Image size 2346x1568.
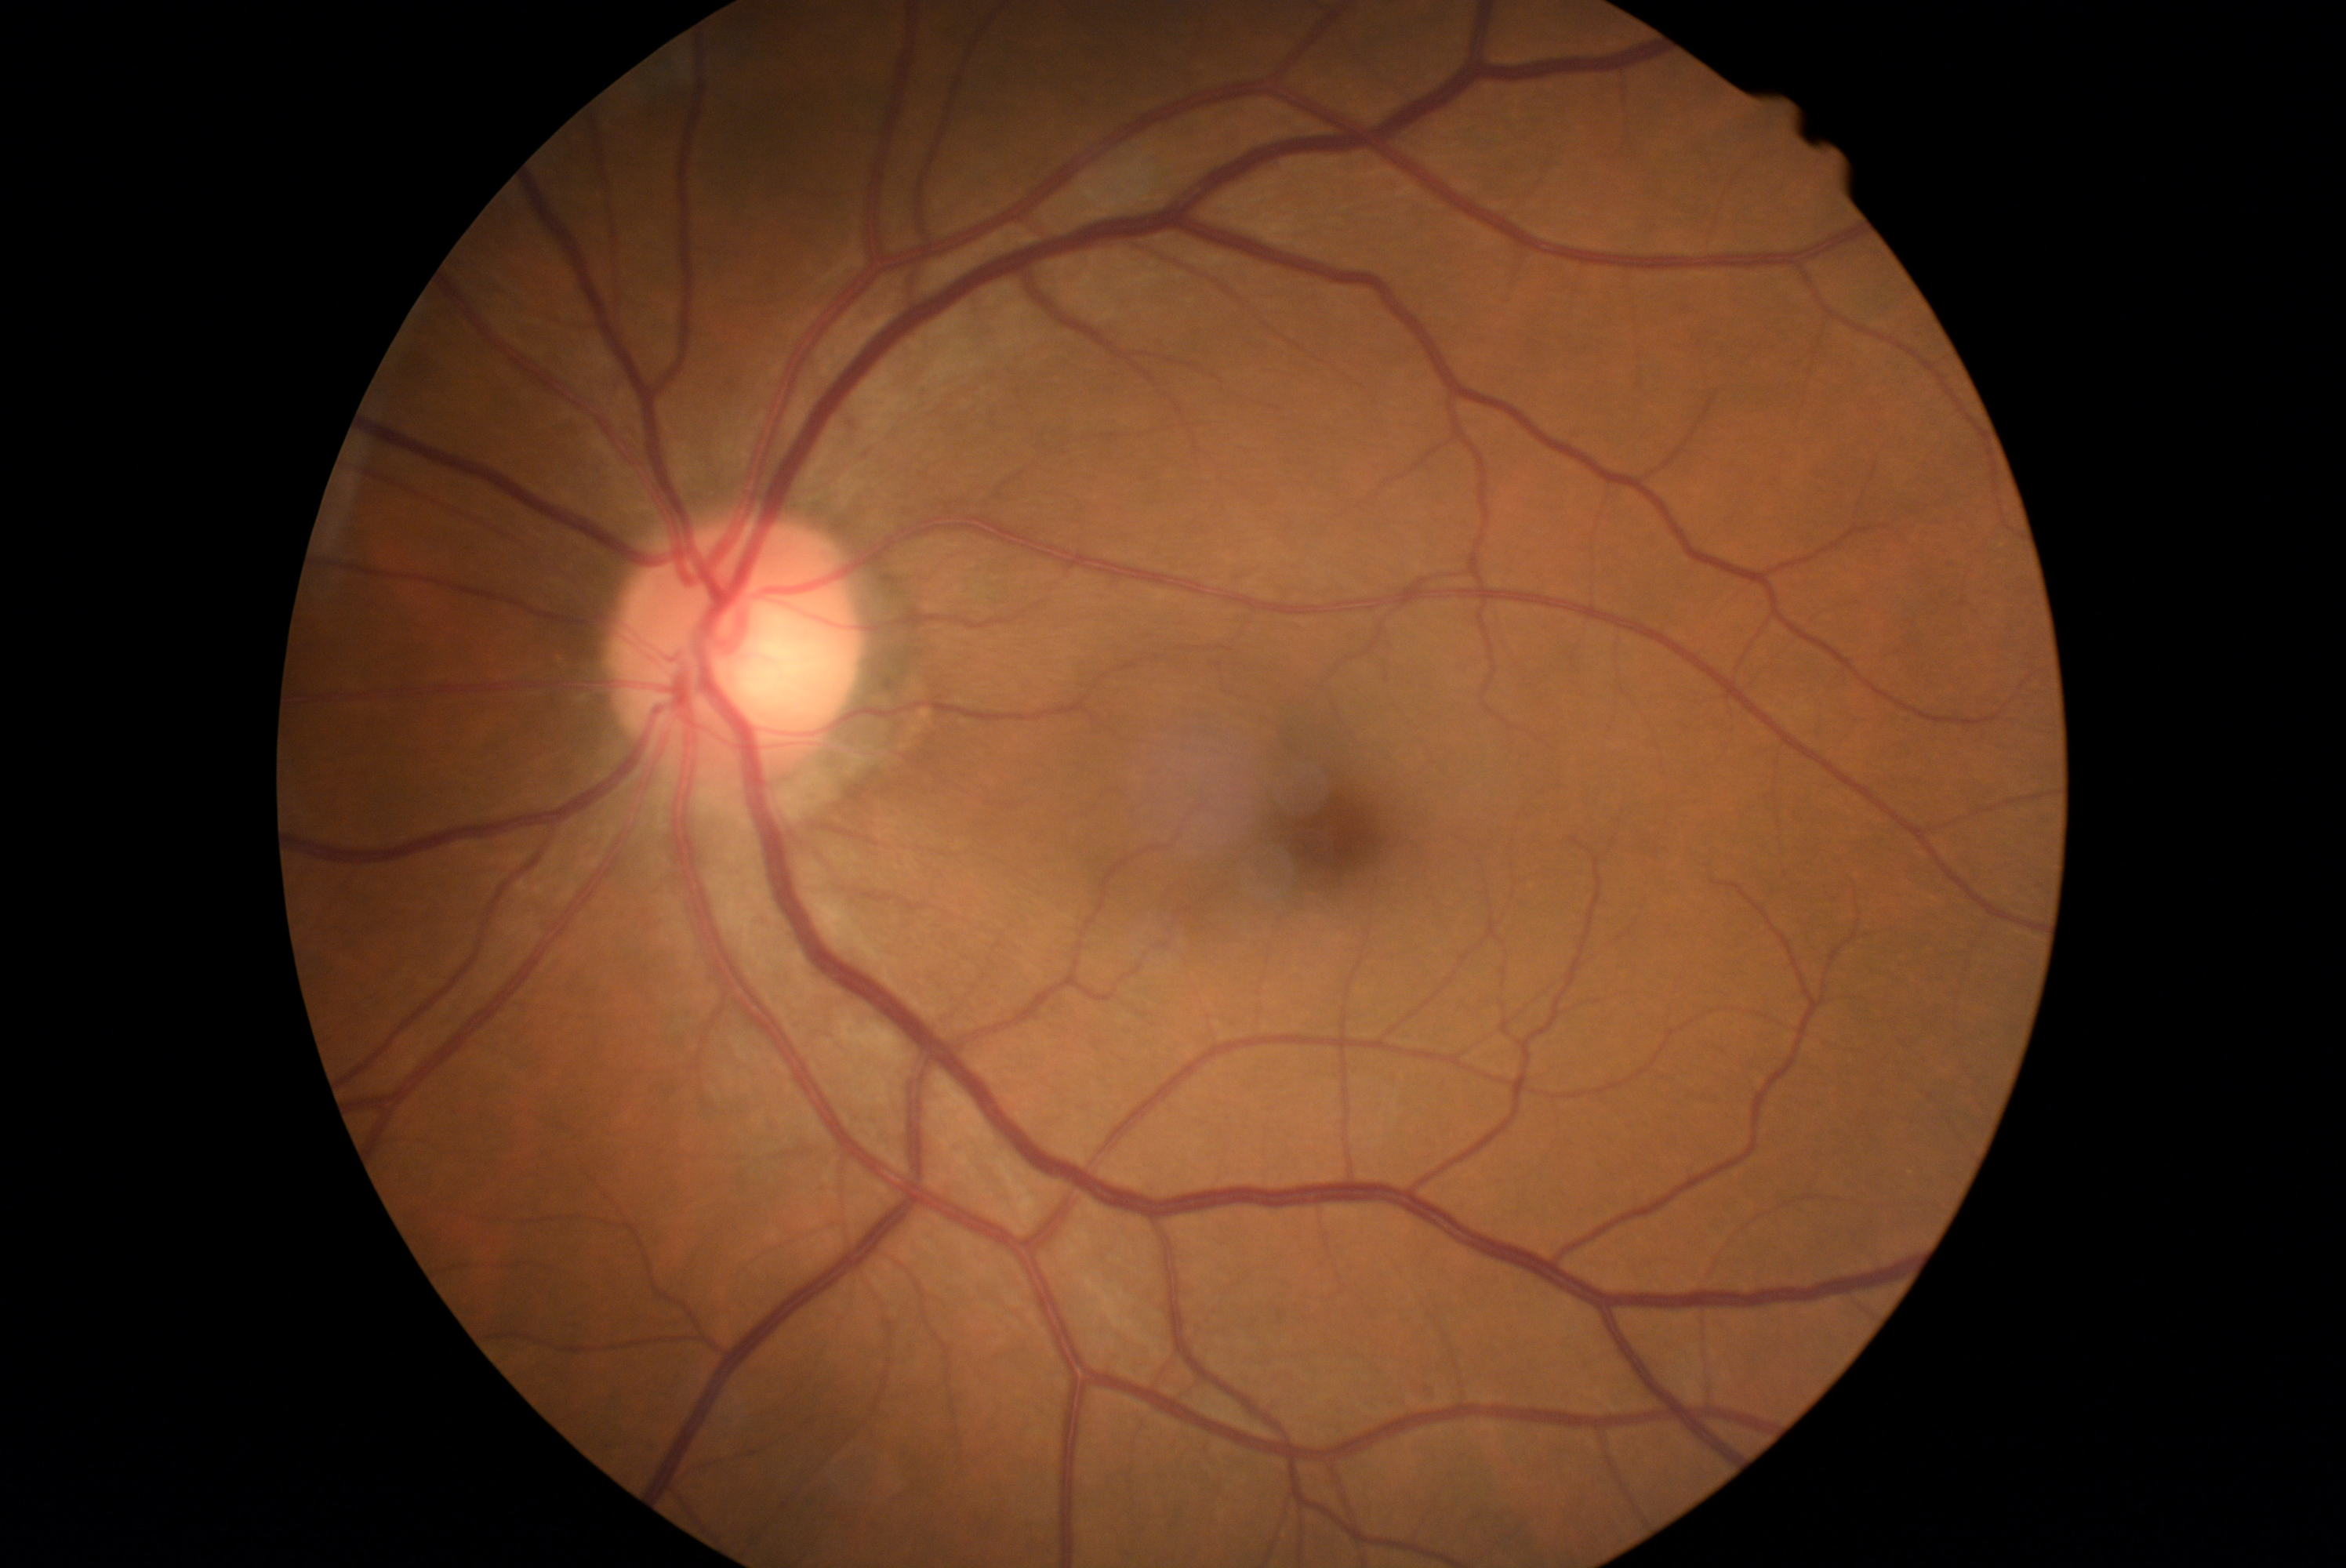
retinopathy grade=0, DR impression=negative for DR.